FOV: 45 degrees
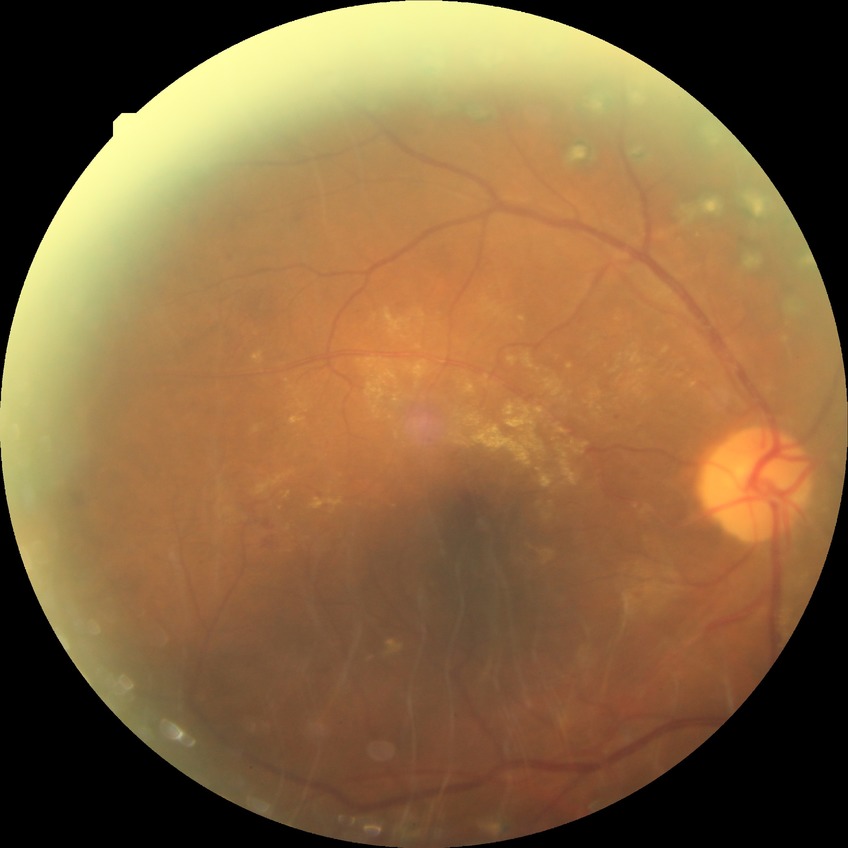

Diabetic retinopathy stage: proliferative diabetic retinopathy.